Retinal fundus photograph — 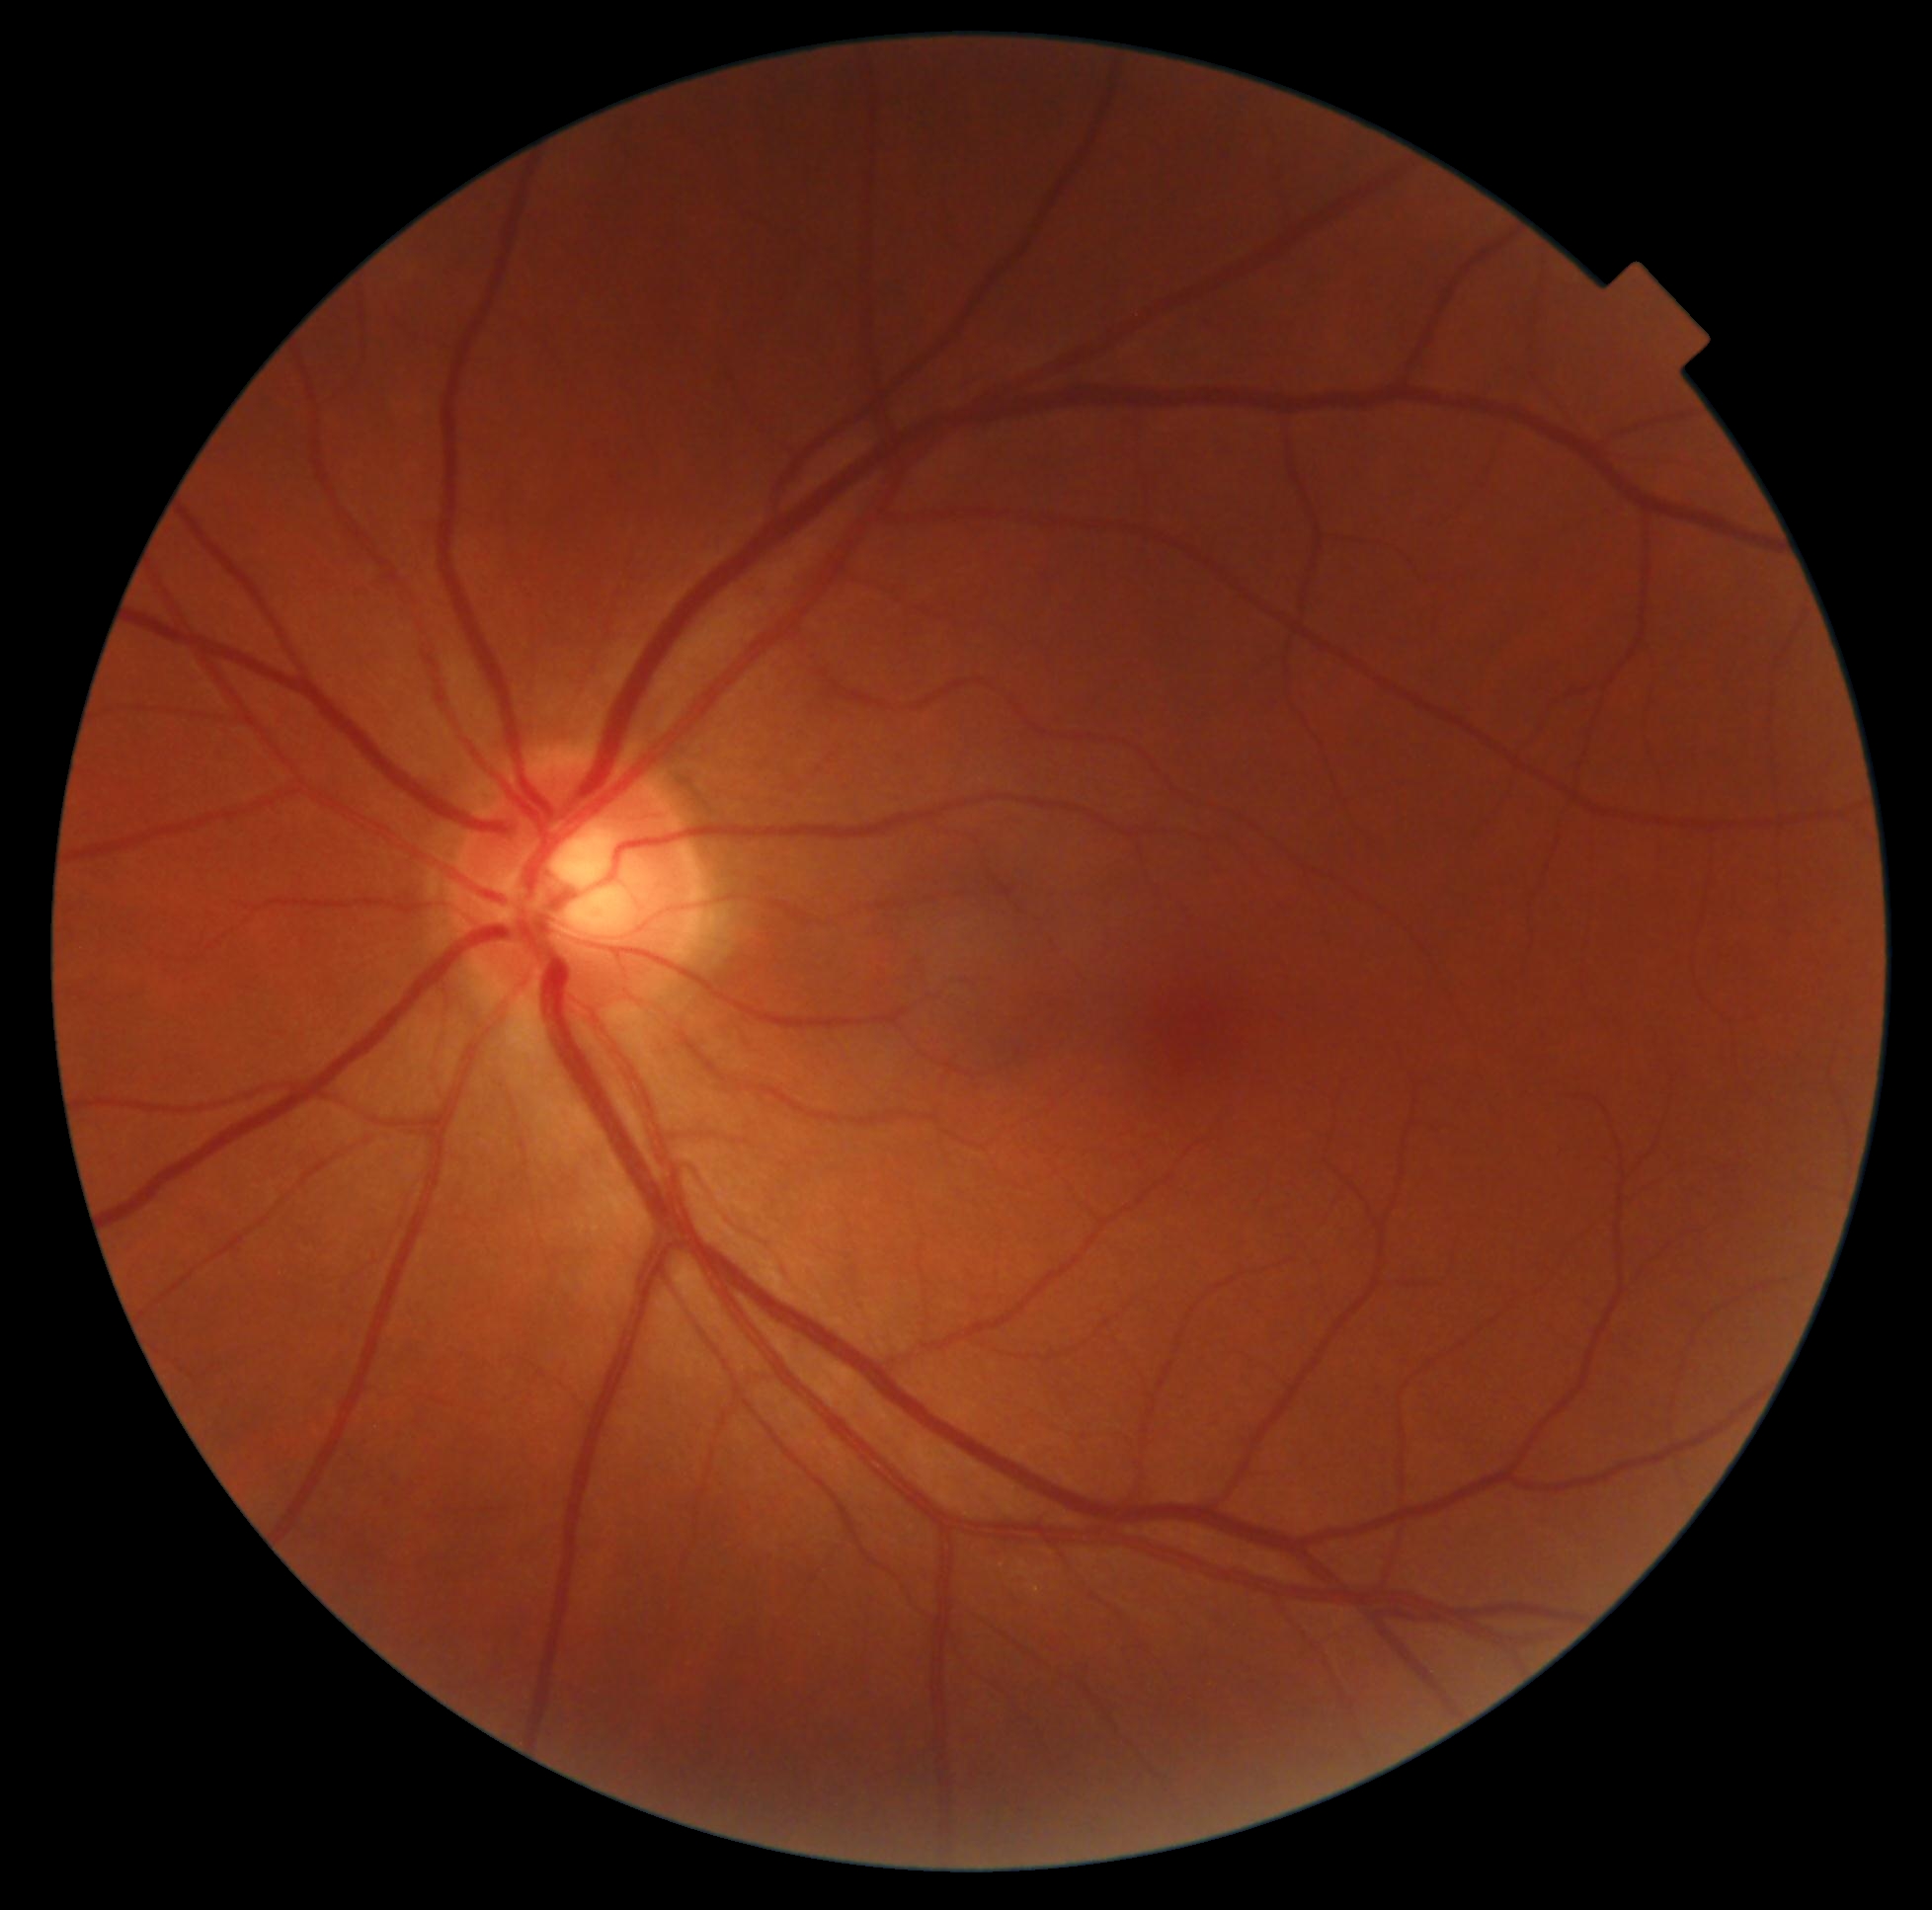 diabetic retinopathy (DR)@no apparent retinopathy (grade 0).